Pediatric wide-field fundus photograph; captured with the Clarity RetCam 3 (130° field of view):
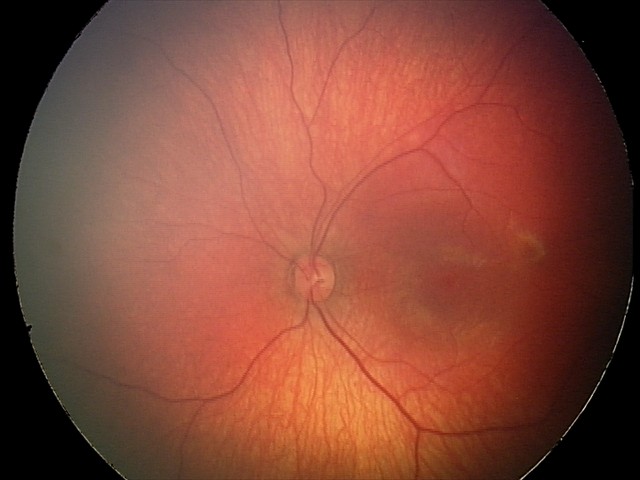 Screening series with retinal hemorrhages.